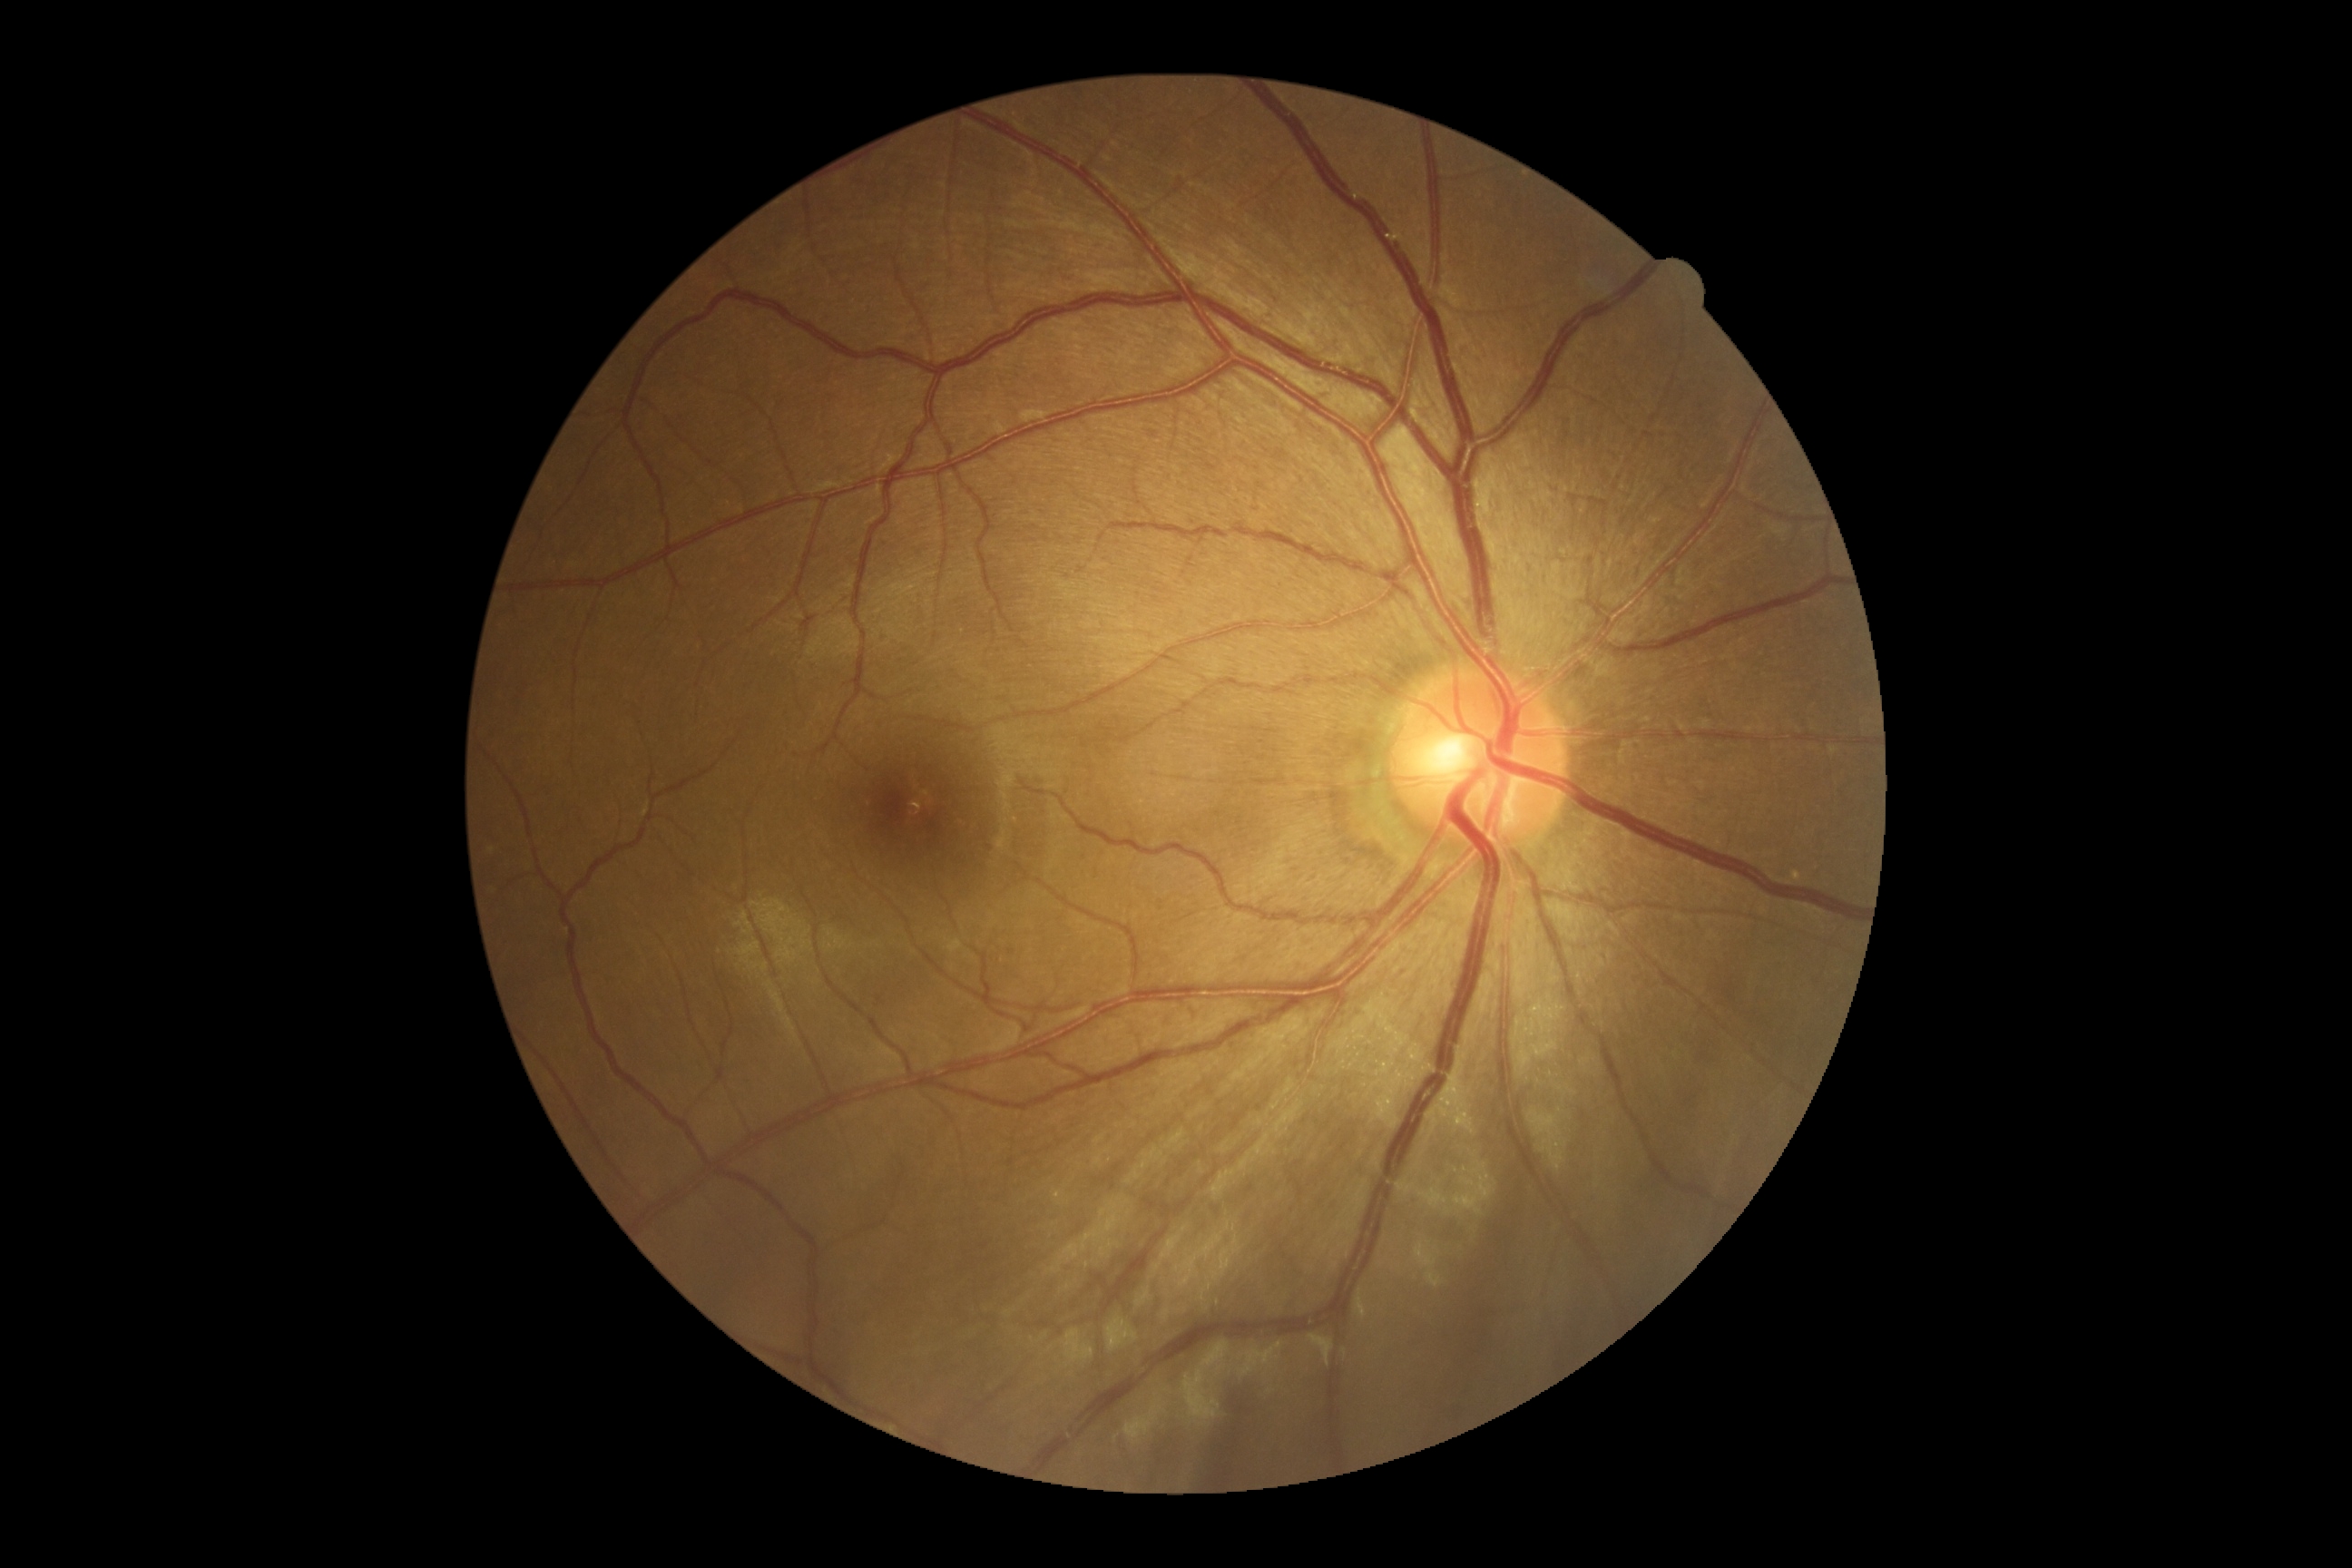

No signs of diabetic retinopathy. Diabetic retinopathy severity: 0.